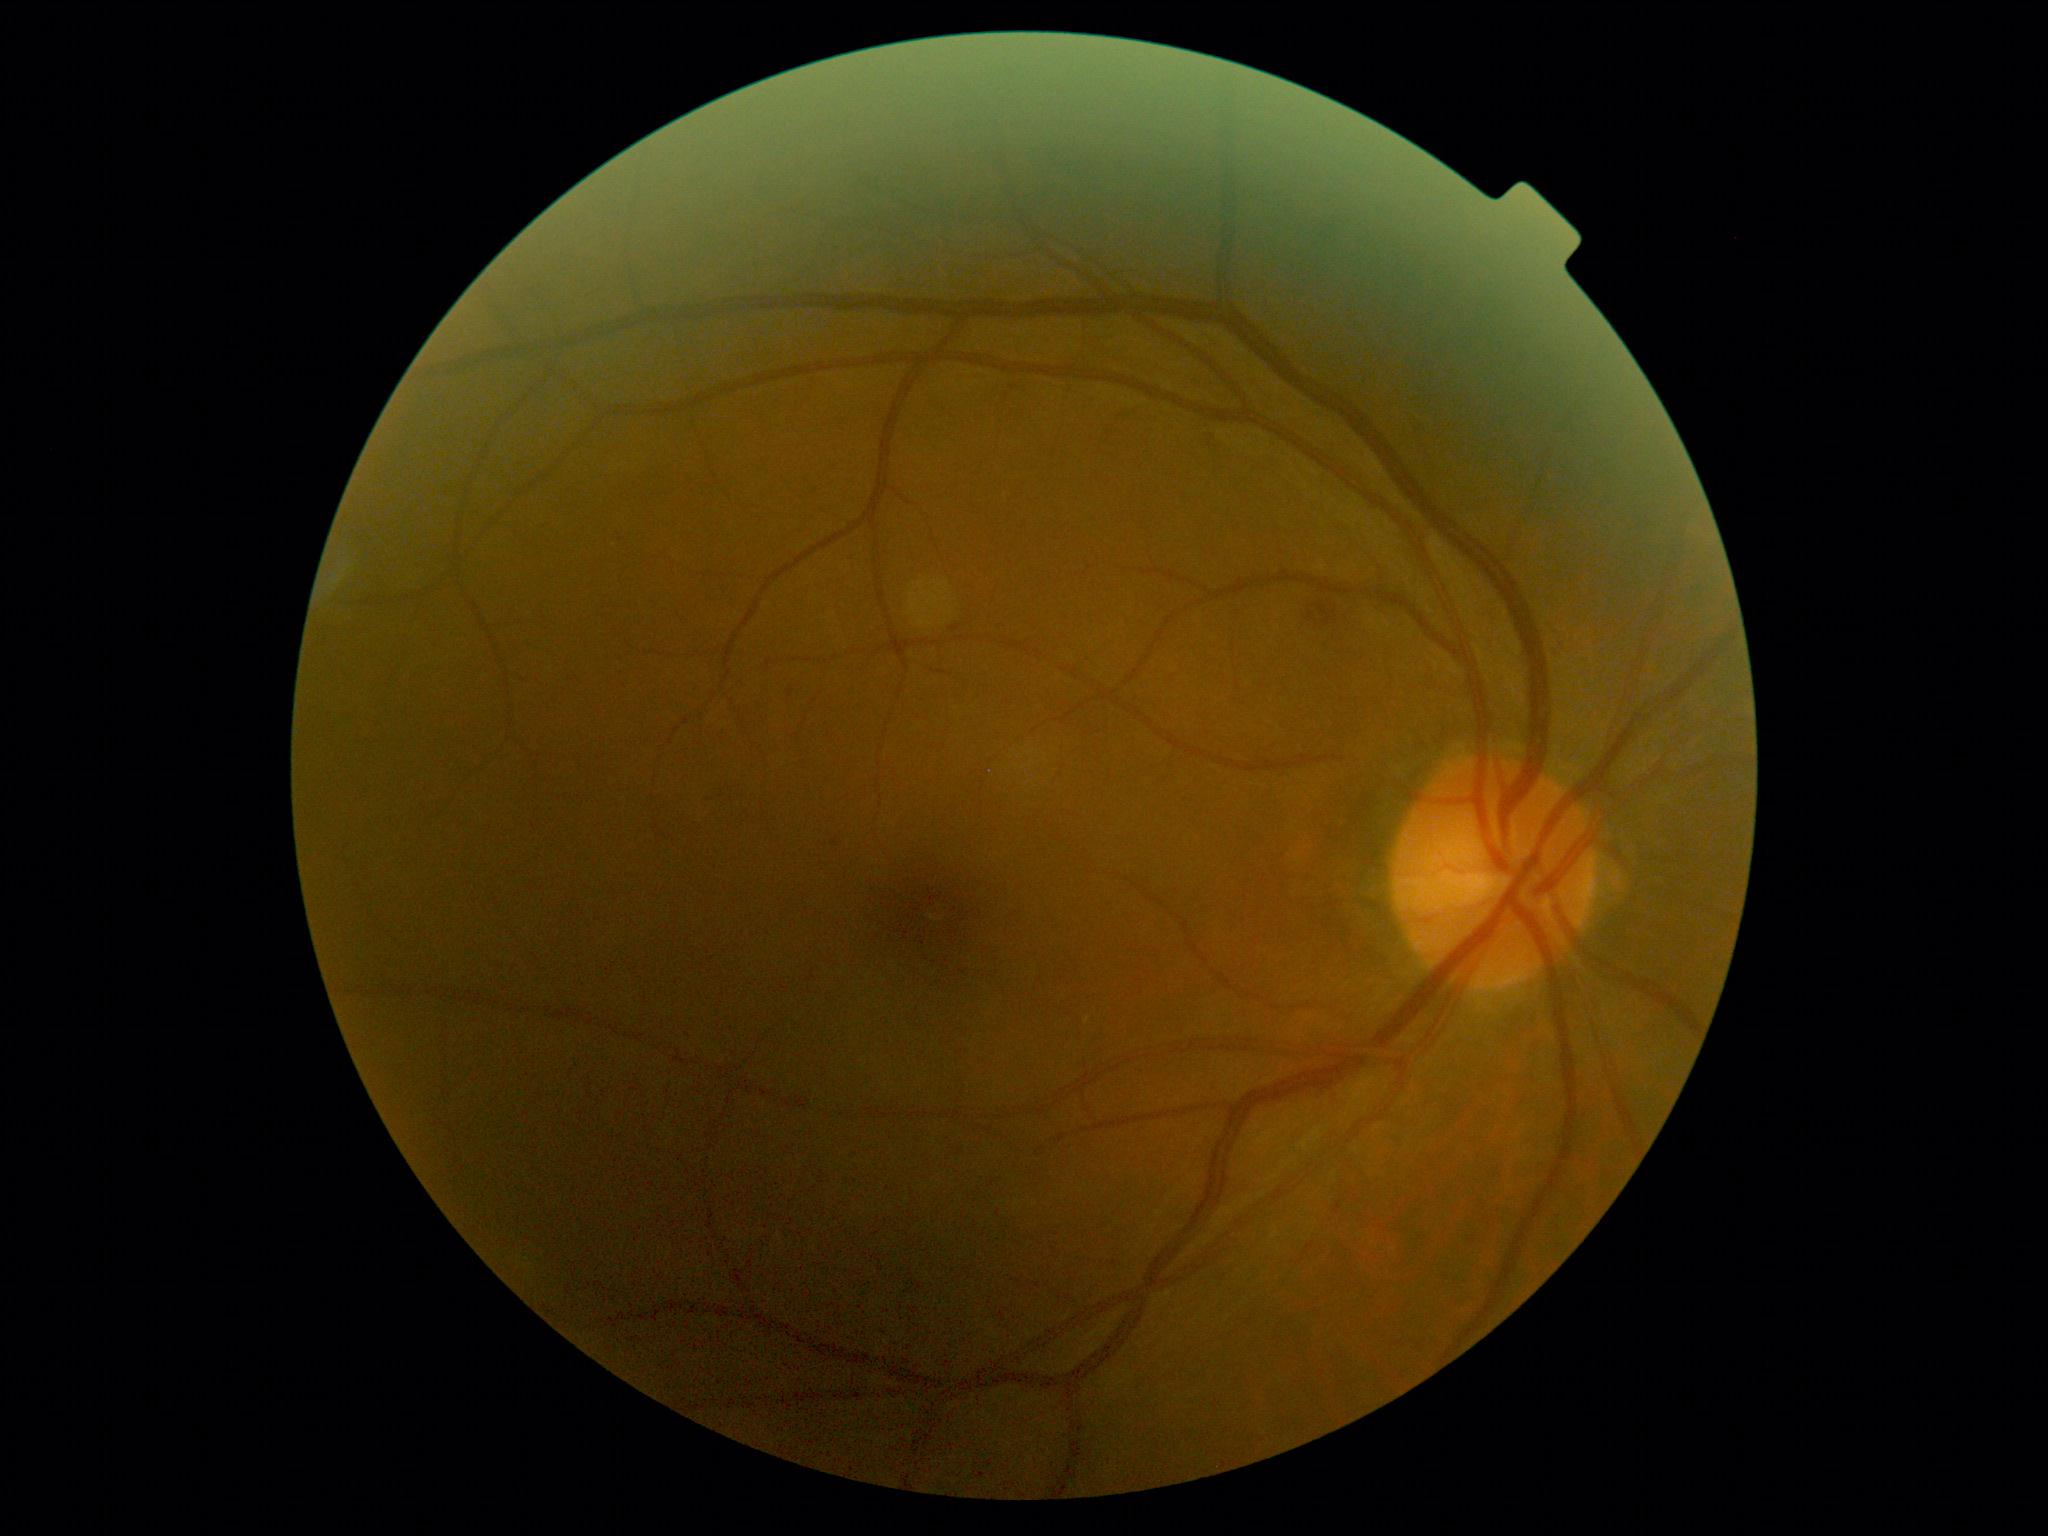 DR class = non-proliferative diabetic retinopathy, retinopathy grade = moderate NPDR (2).